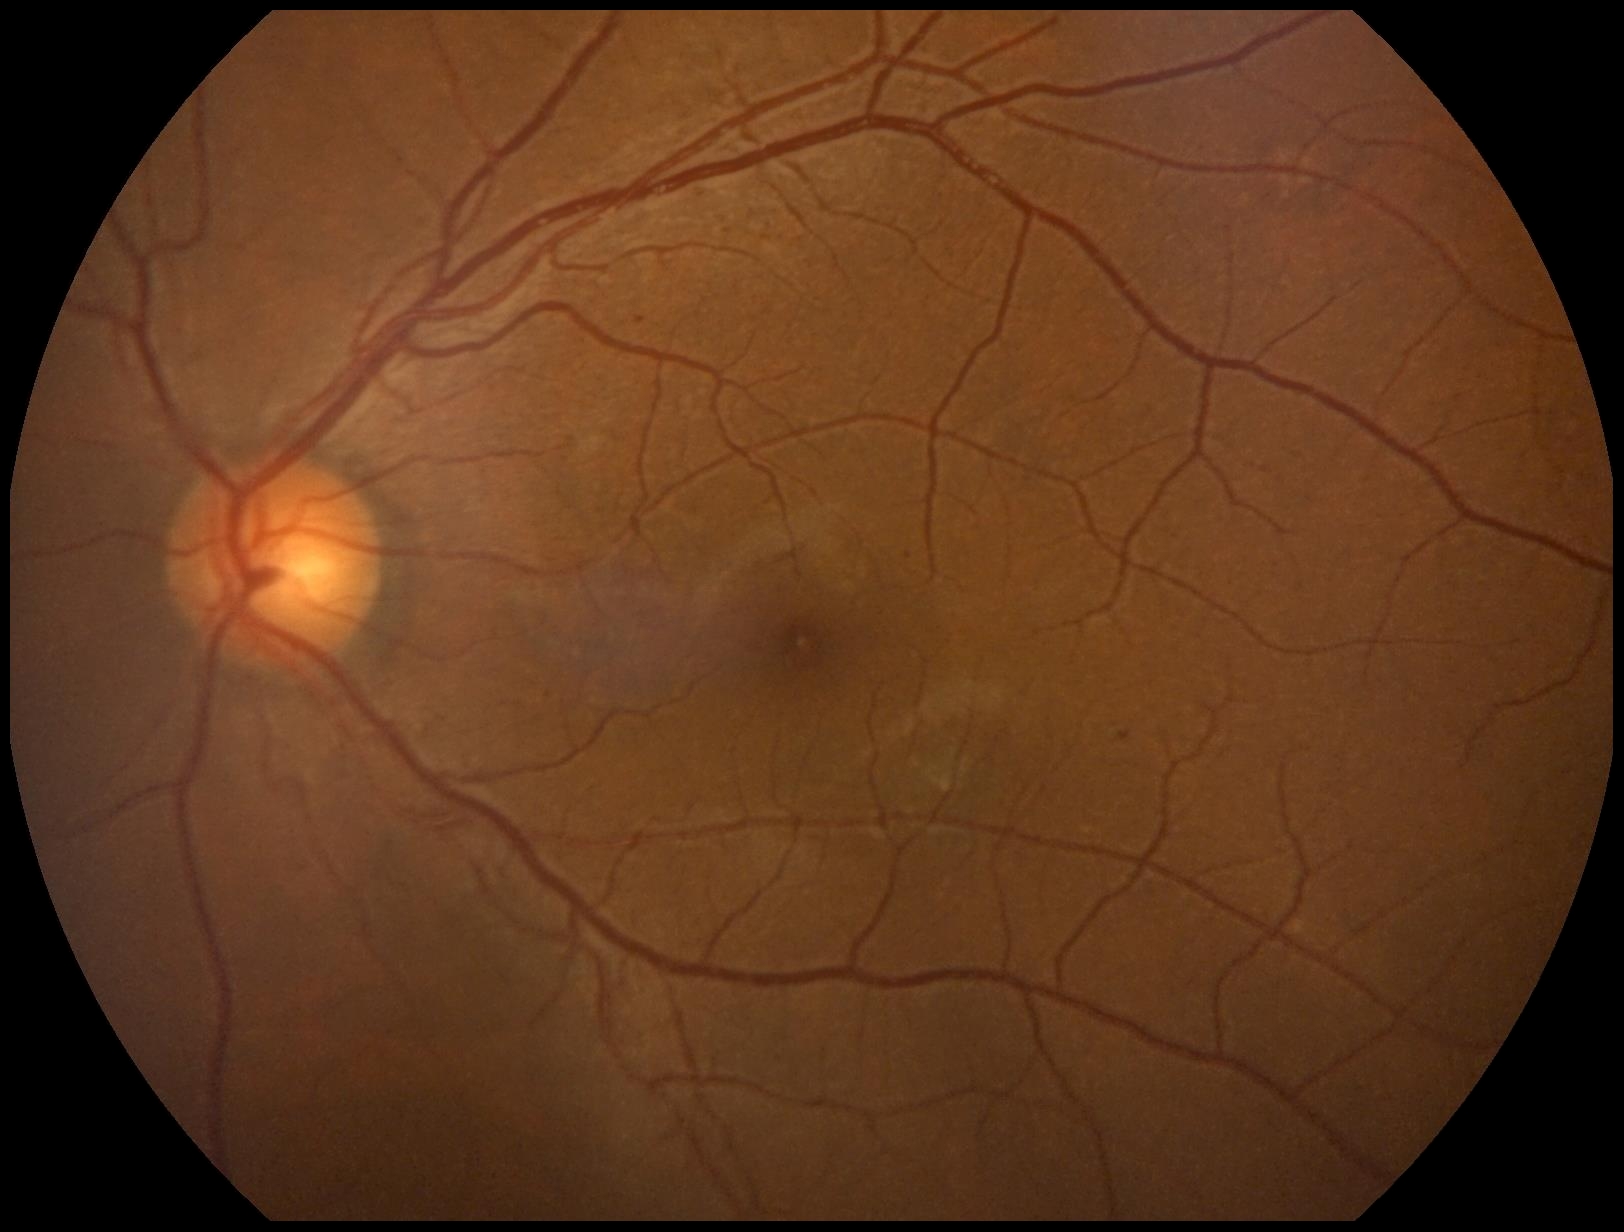

DR: grade 1 (mild NPDR) — presence of microaneurysms only
EXs: not present
MAs: 636:318:645:324; 1119:733:1131:742
Small MAs approximately at x=549 y=696; x=909 y=556
HEs: not present
SEs: not present